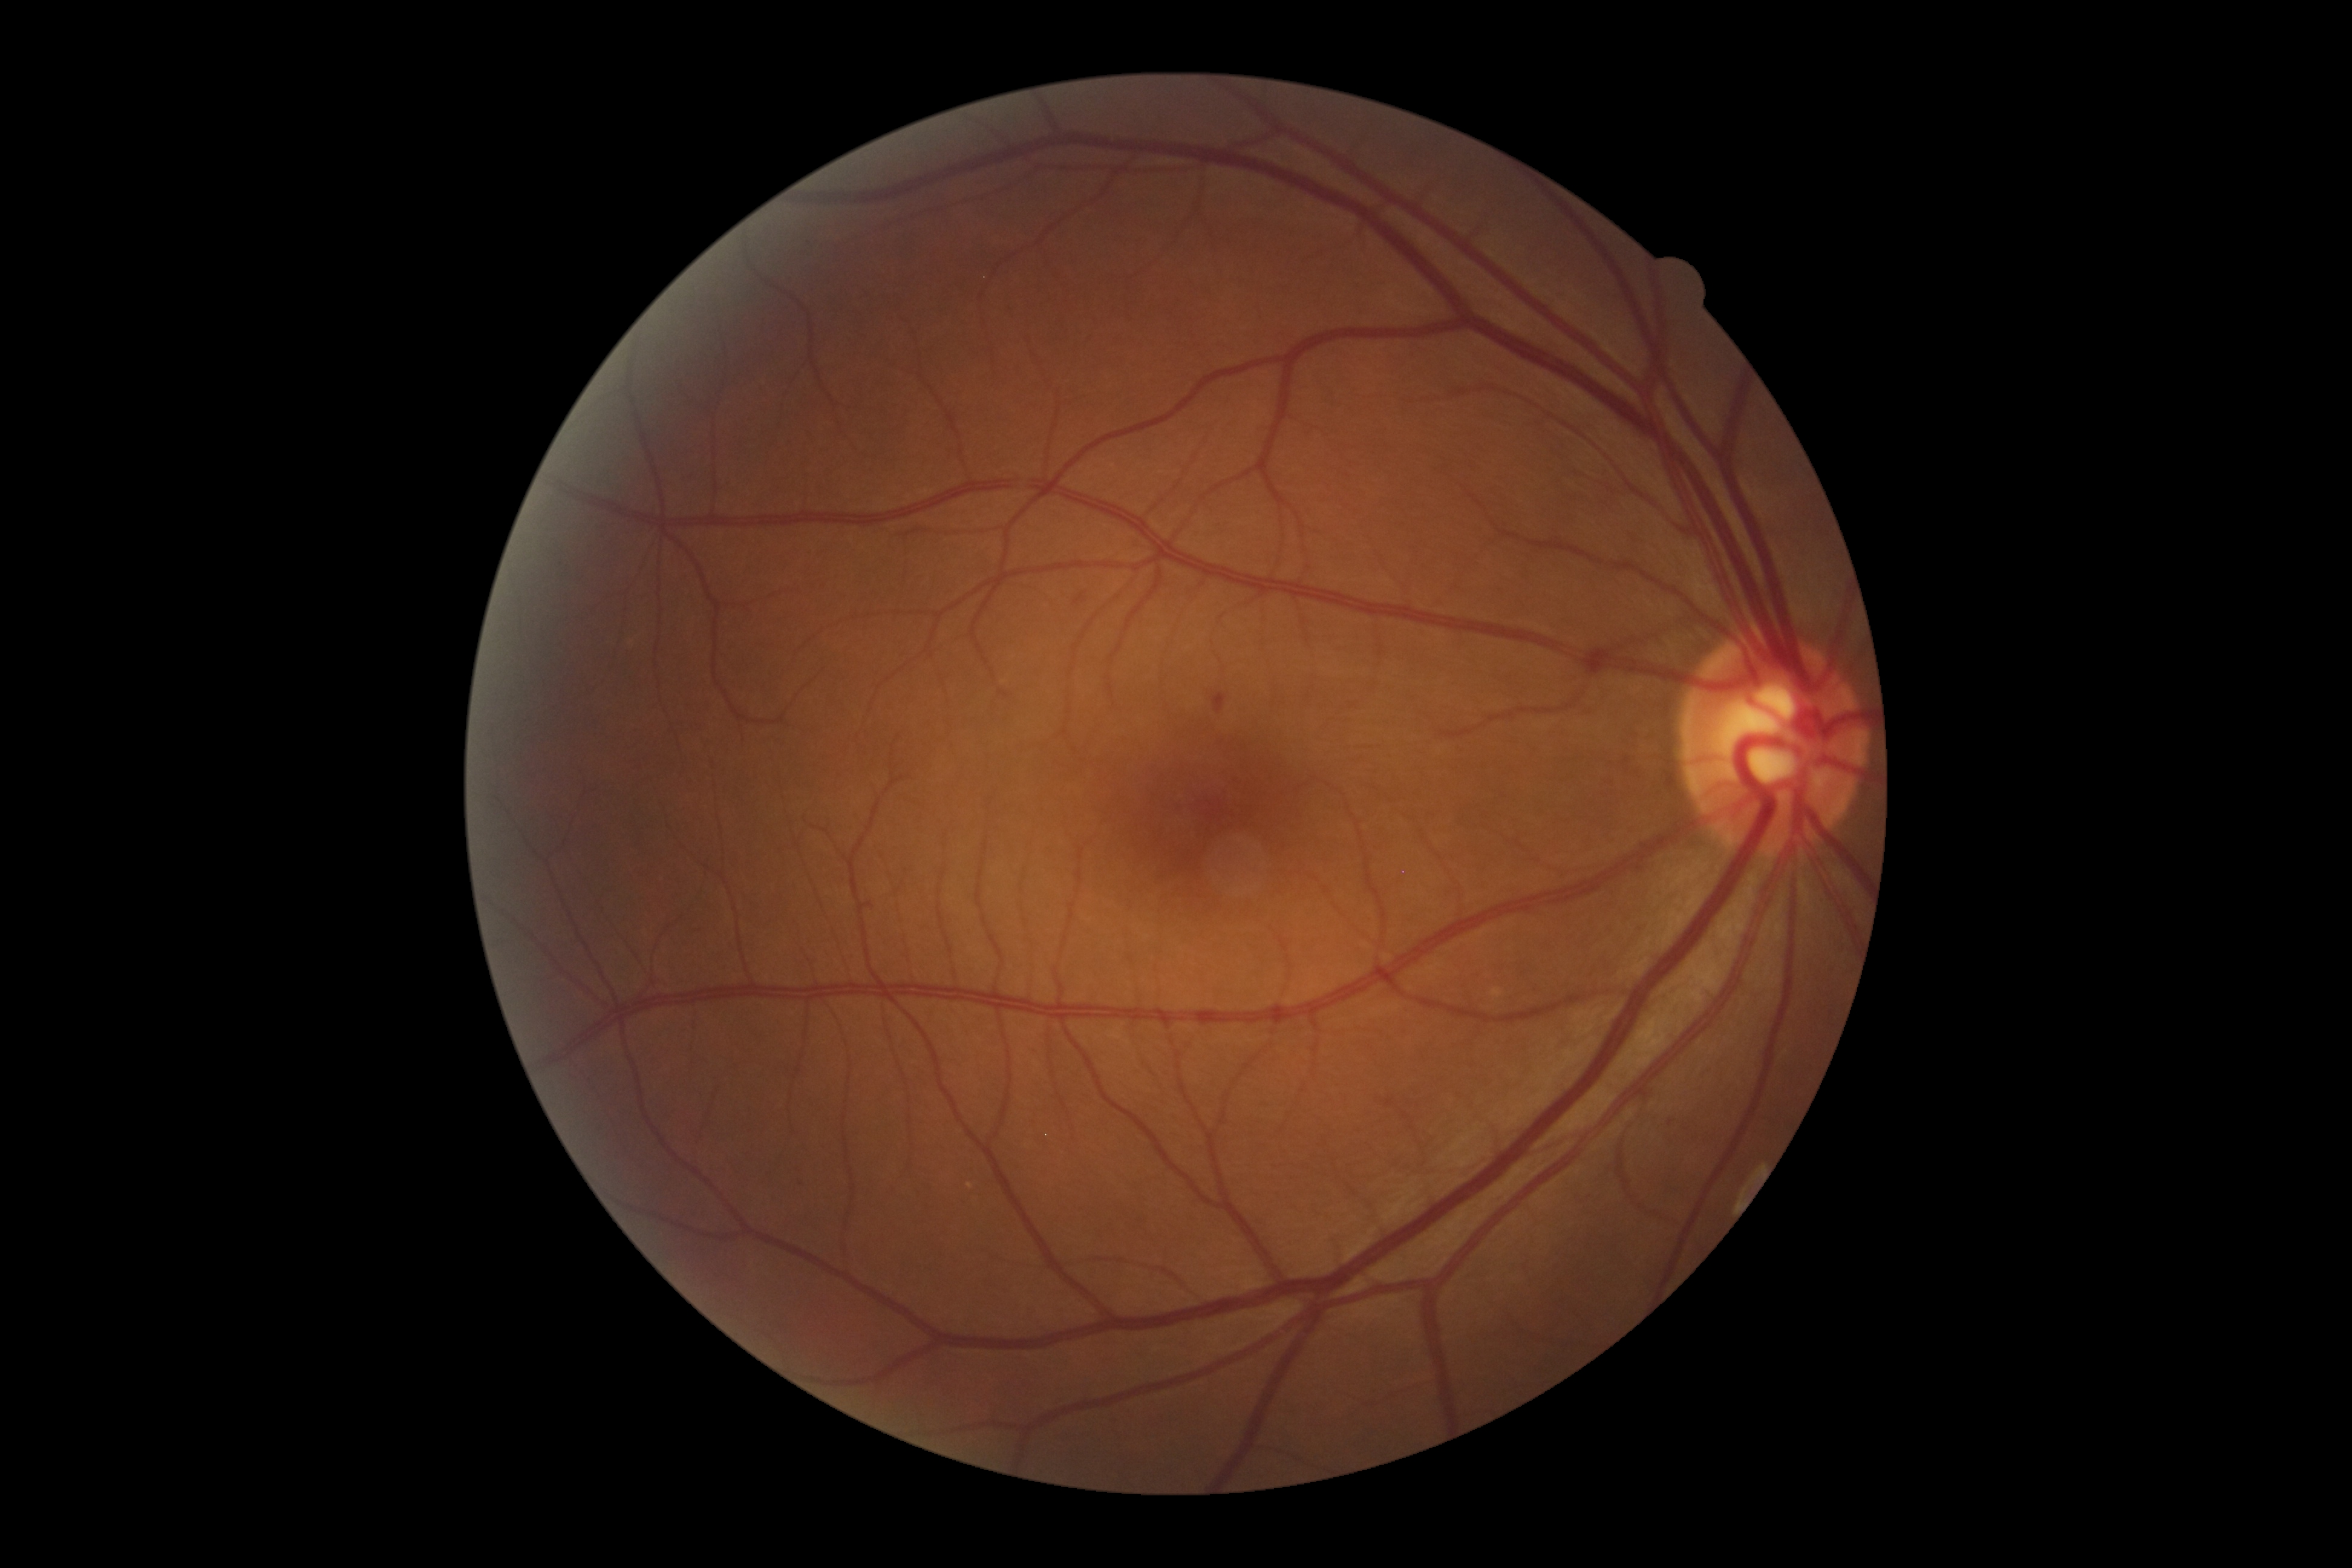 {"dr_grade": "grade 2", "dr_category": "non-proliferative diabetic retinopathy"}